Davis DR grading · acquired with a NIDEK AFC-230 · 848x848: 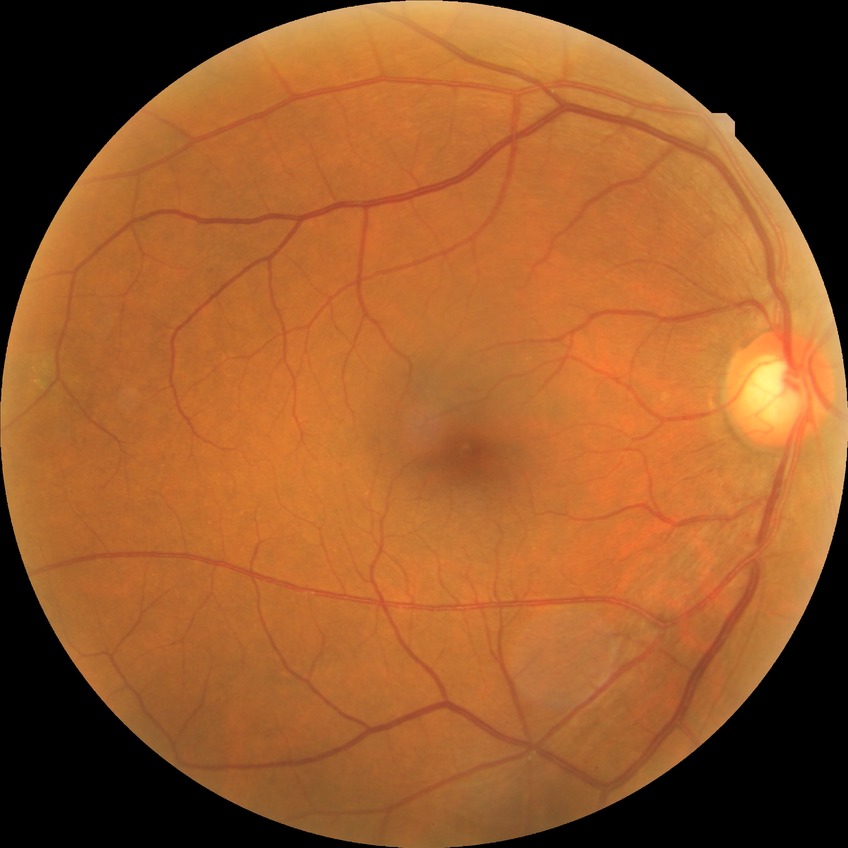 DR: NDR.